Posterior pole view, dilated-pupil acquisition, Topcon TRC-50DX, retinal fundus photograph: 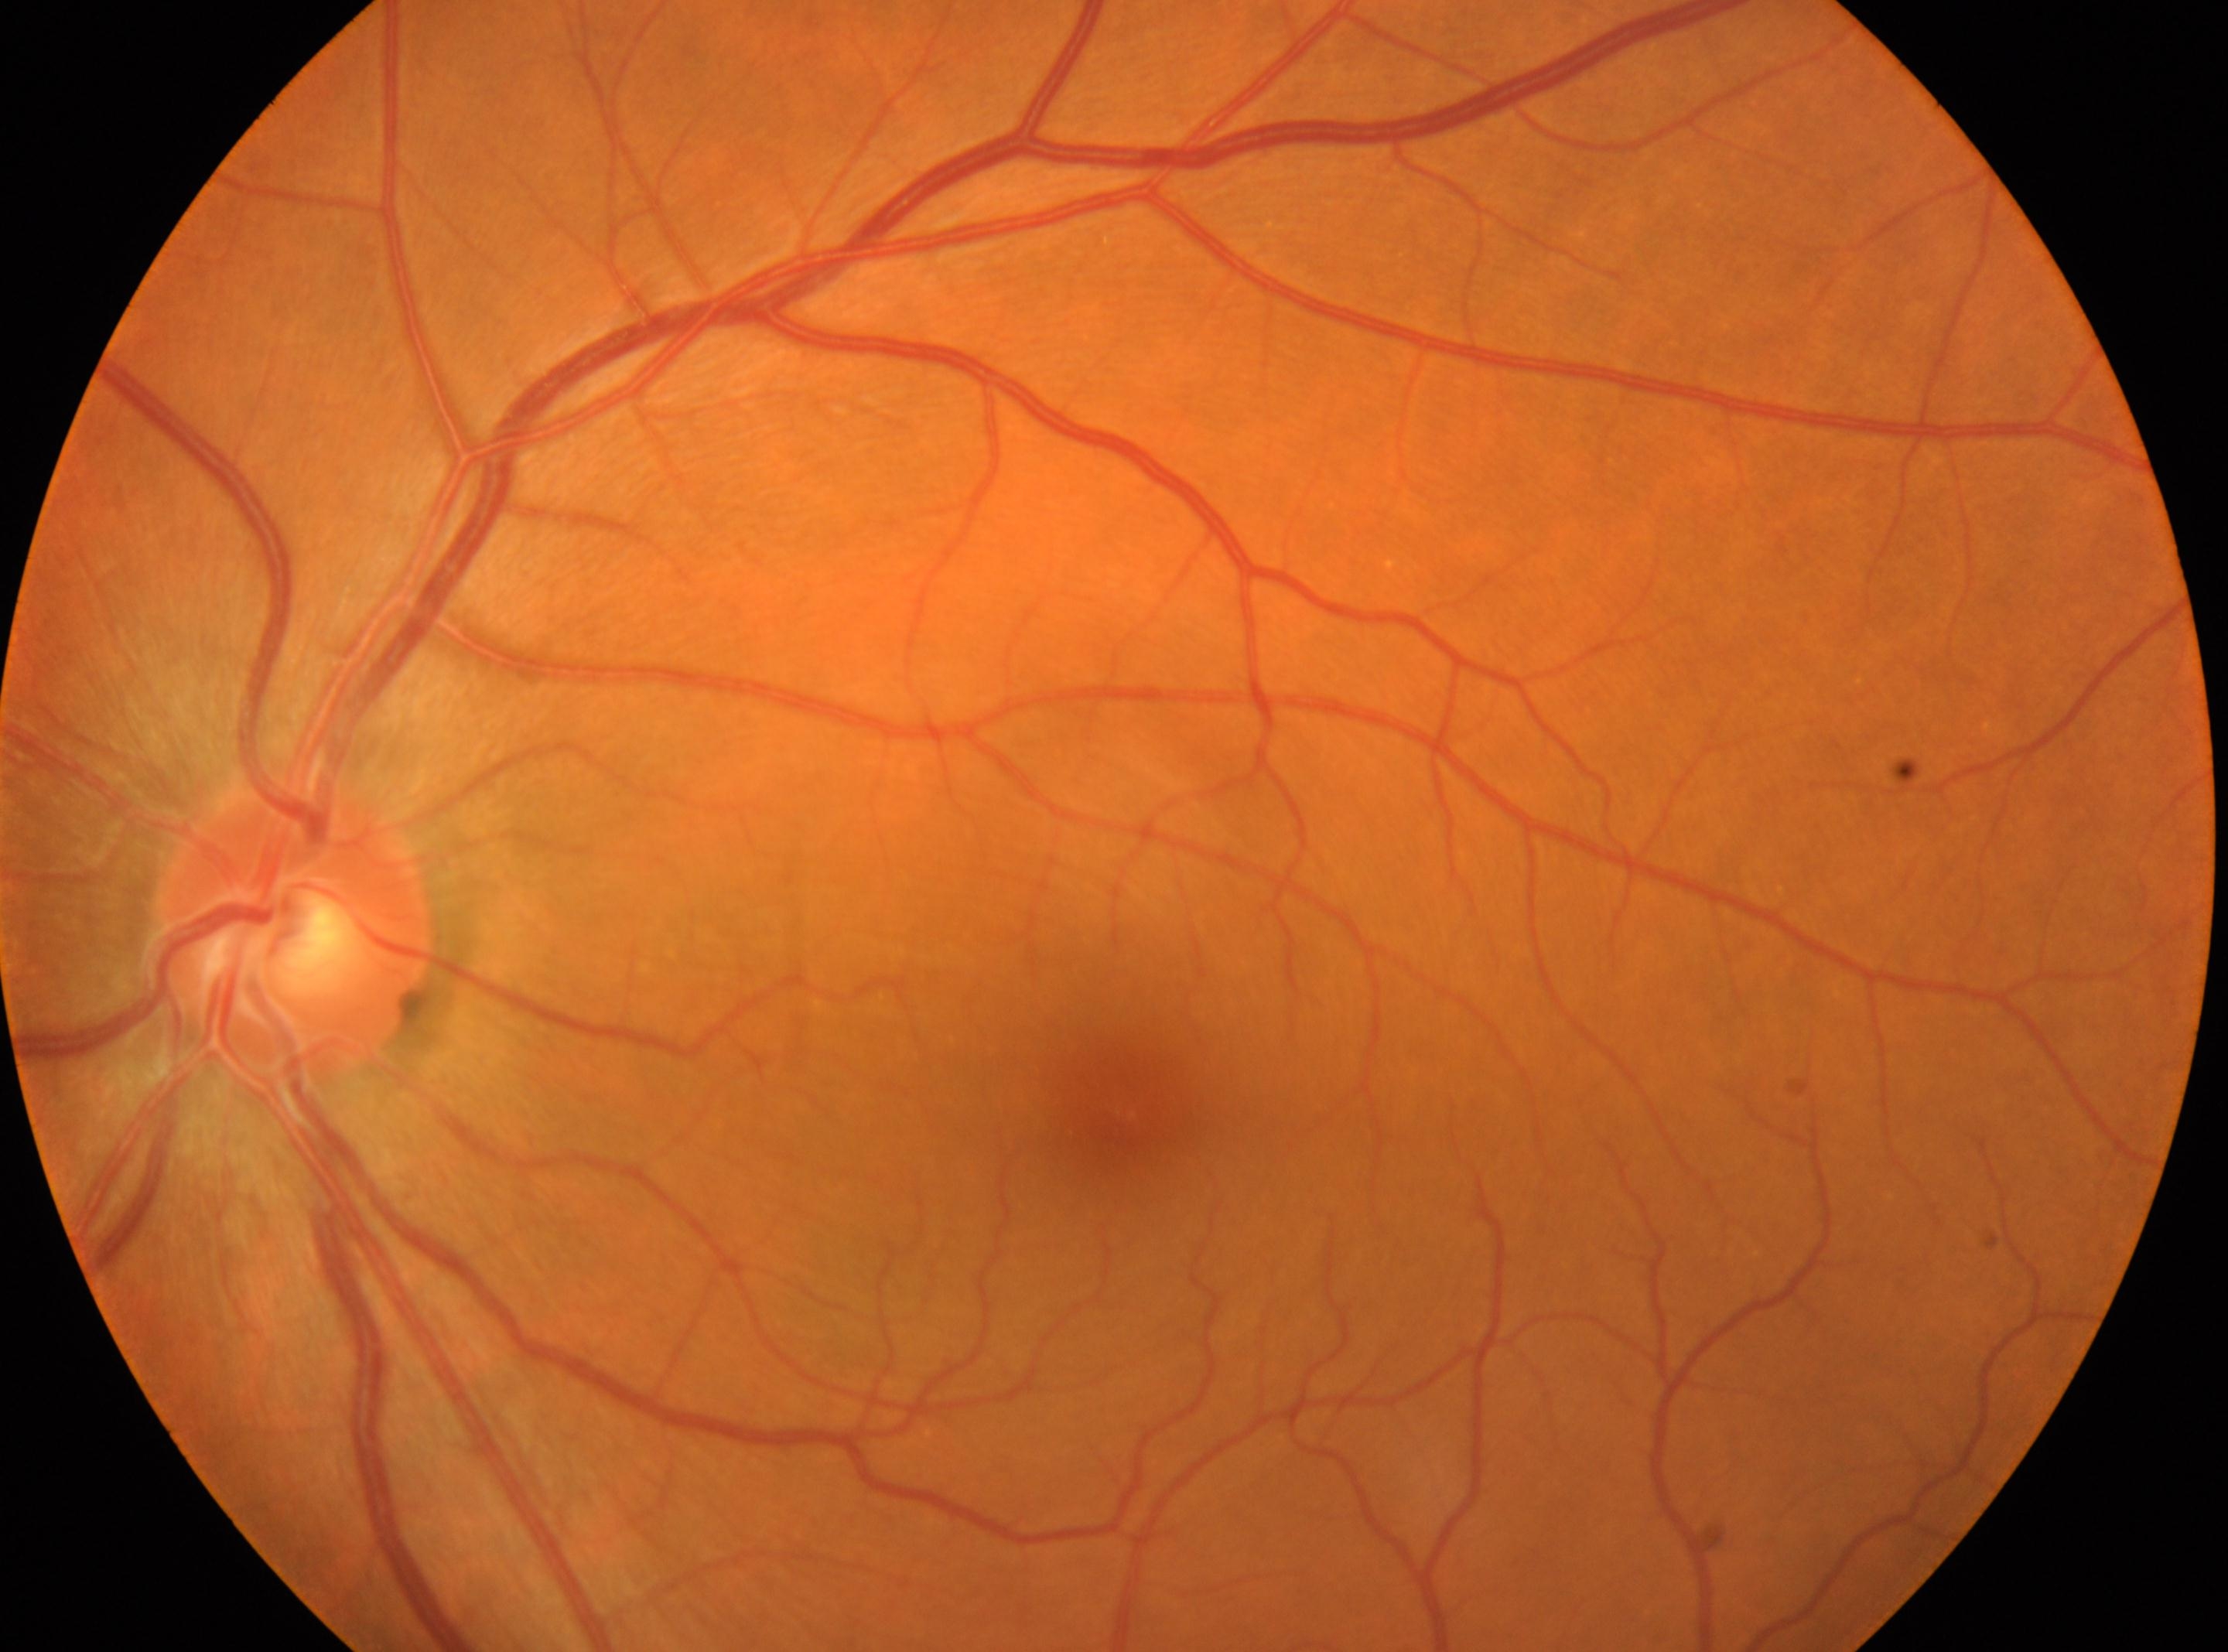
Fovea located at (1122, 1118). Optic nerve head: (292, 932). Diabetic retinopathy (DR): no apparent diabetic retinopathy (grade 0) — no visible signs of diabetic retinopathy. This is the left eye.